2352x1568
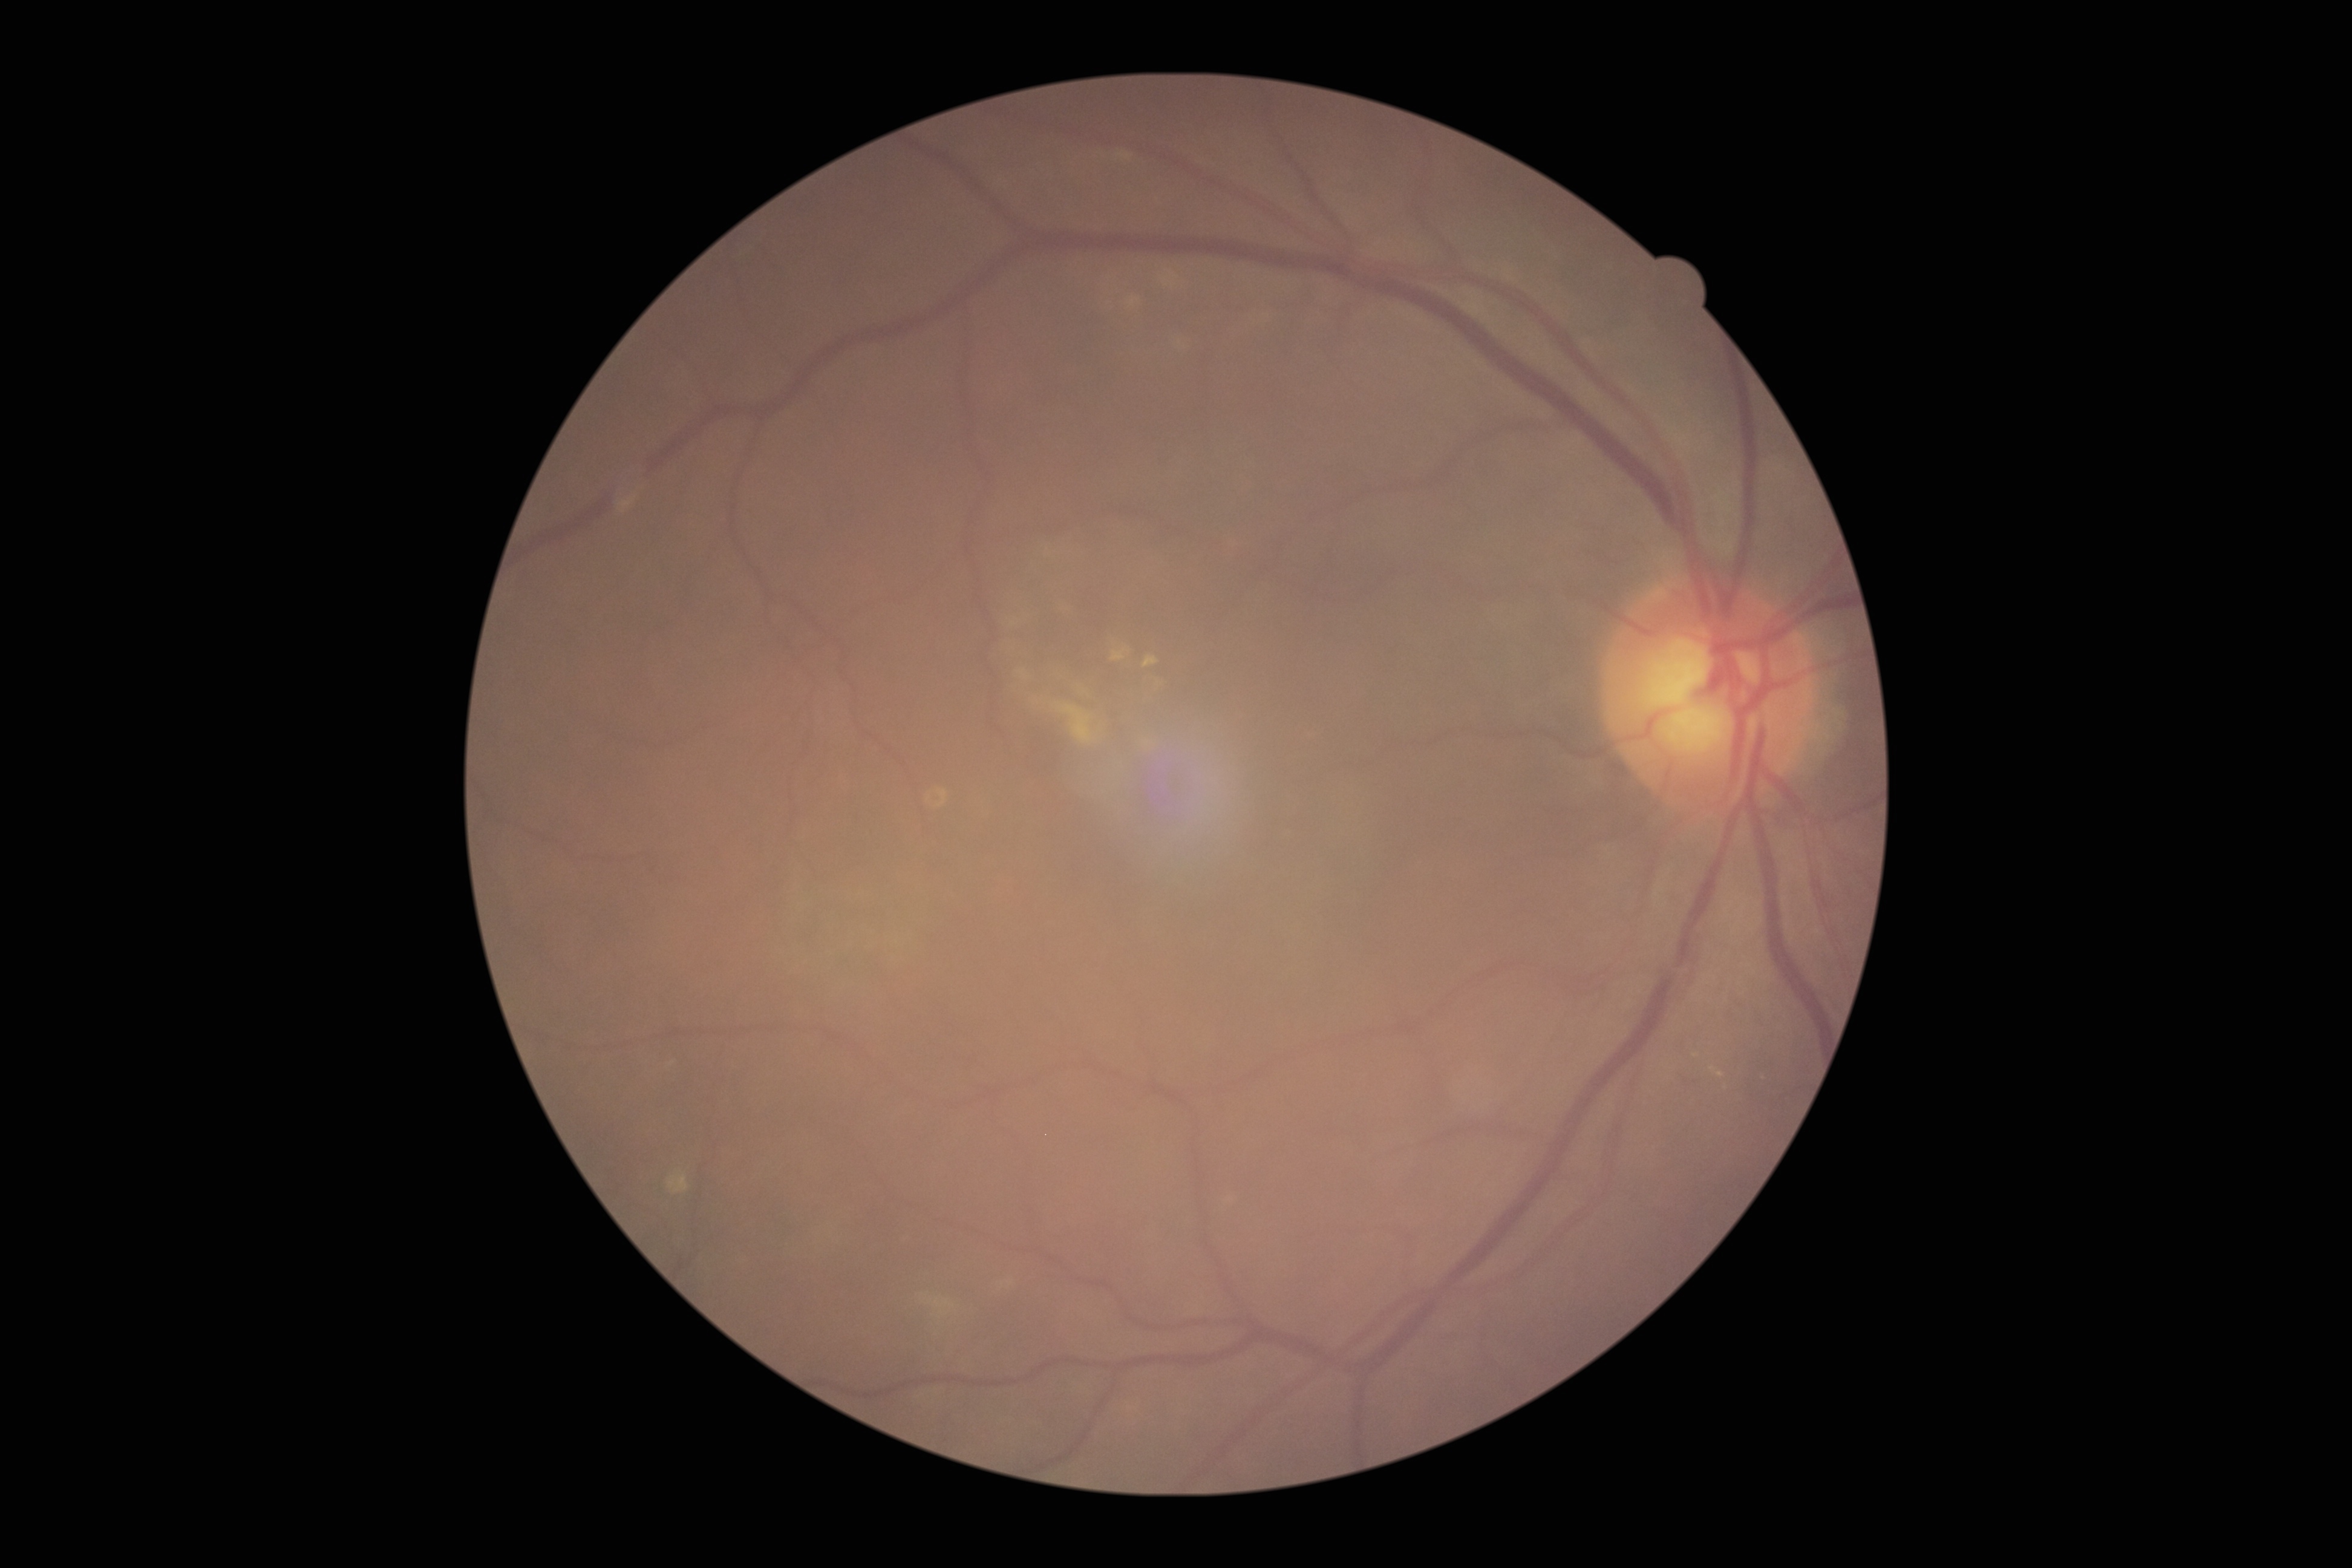

Diabetic retinopathy severity is moderate NPDR (grade 2) — more than just microaneurysms but less than severe NPDR.